45° FOV, 2352x1568px, color fundus image: 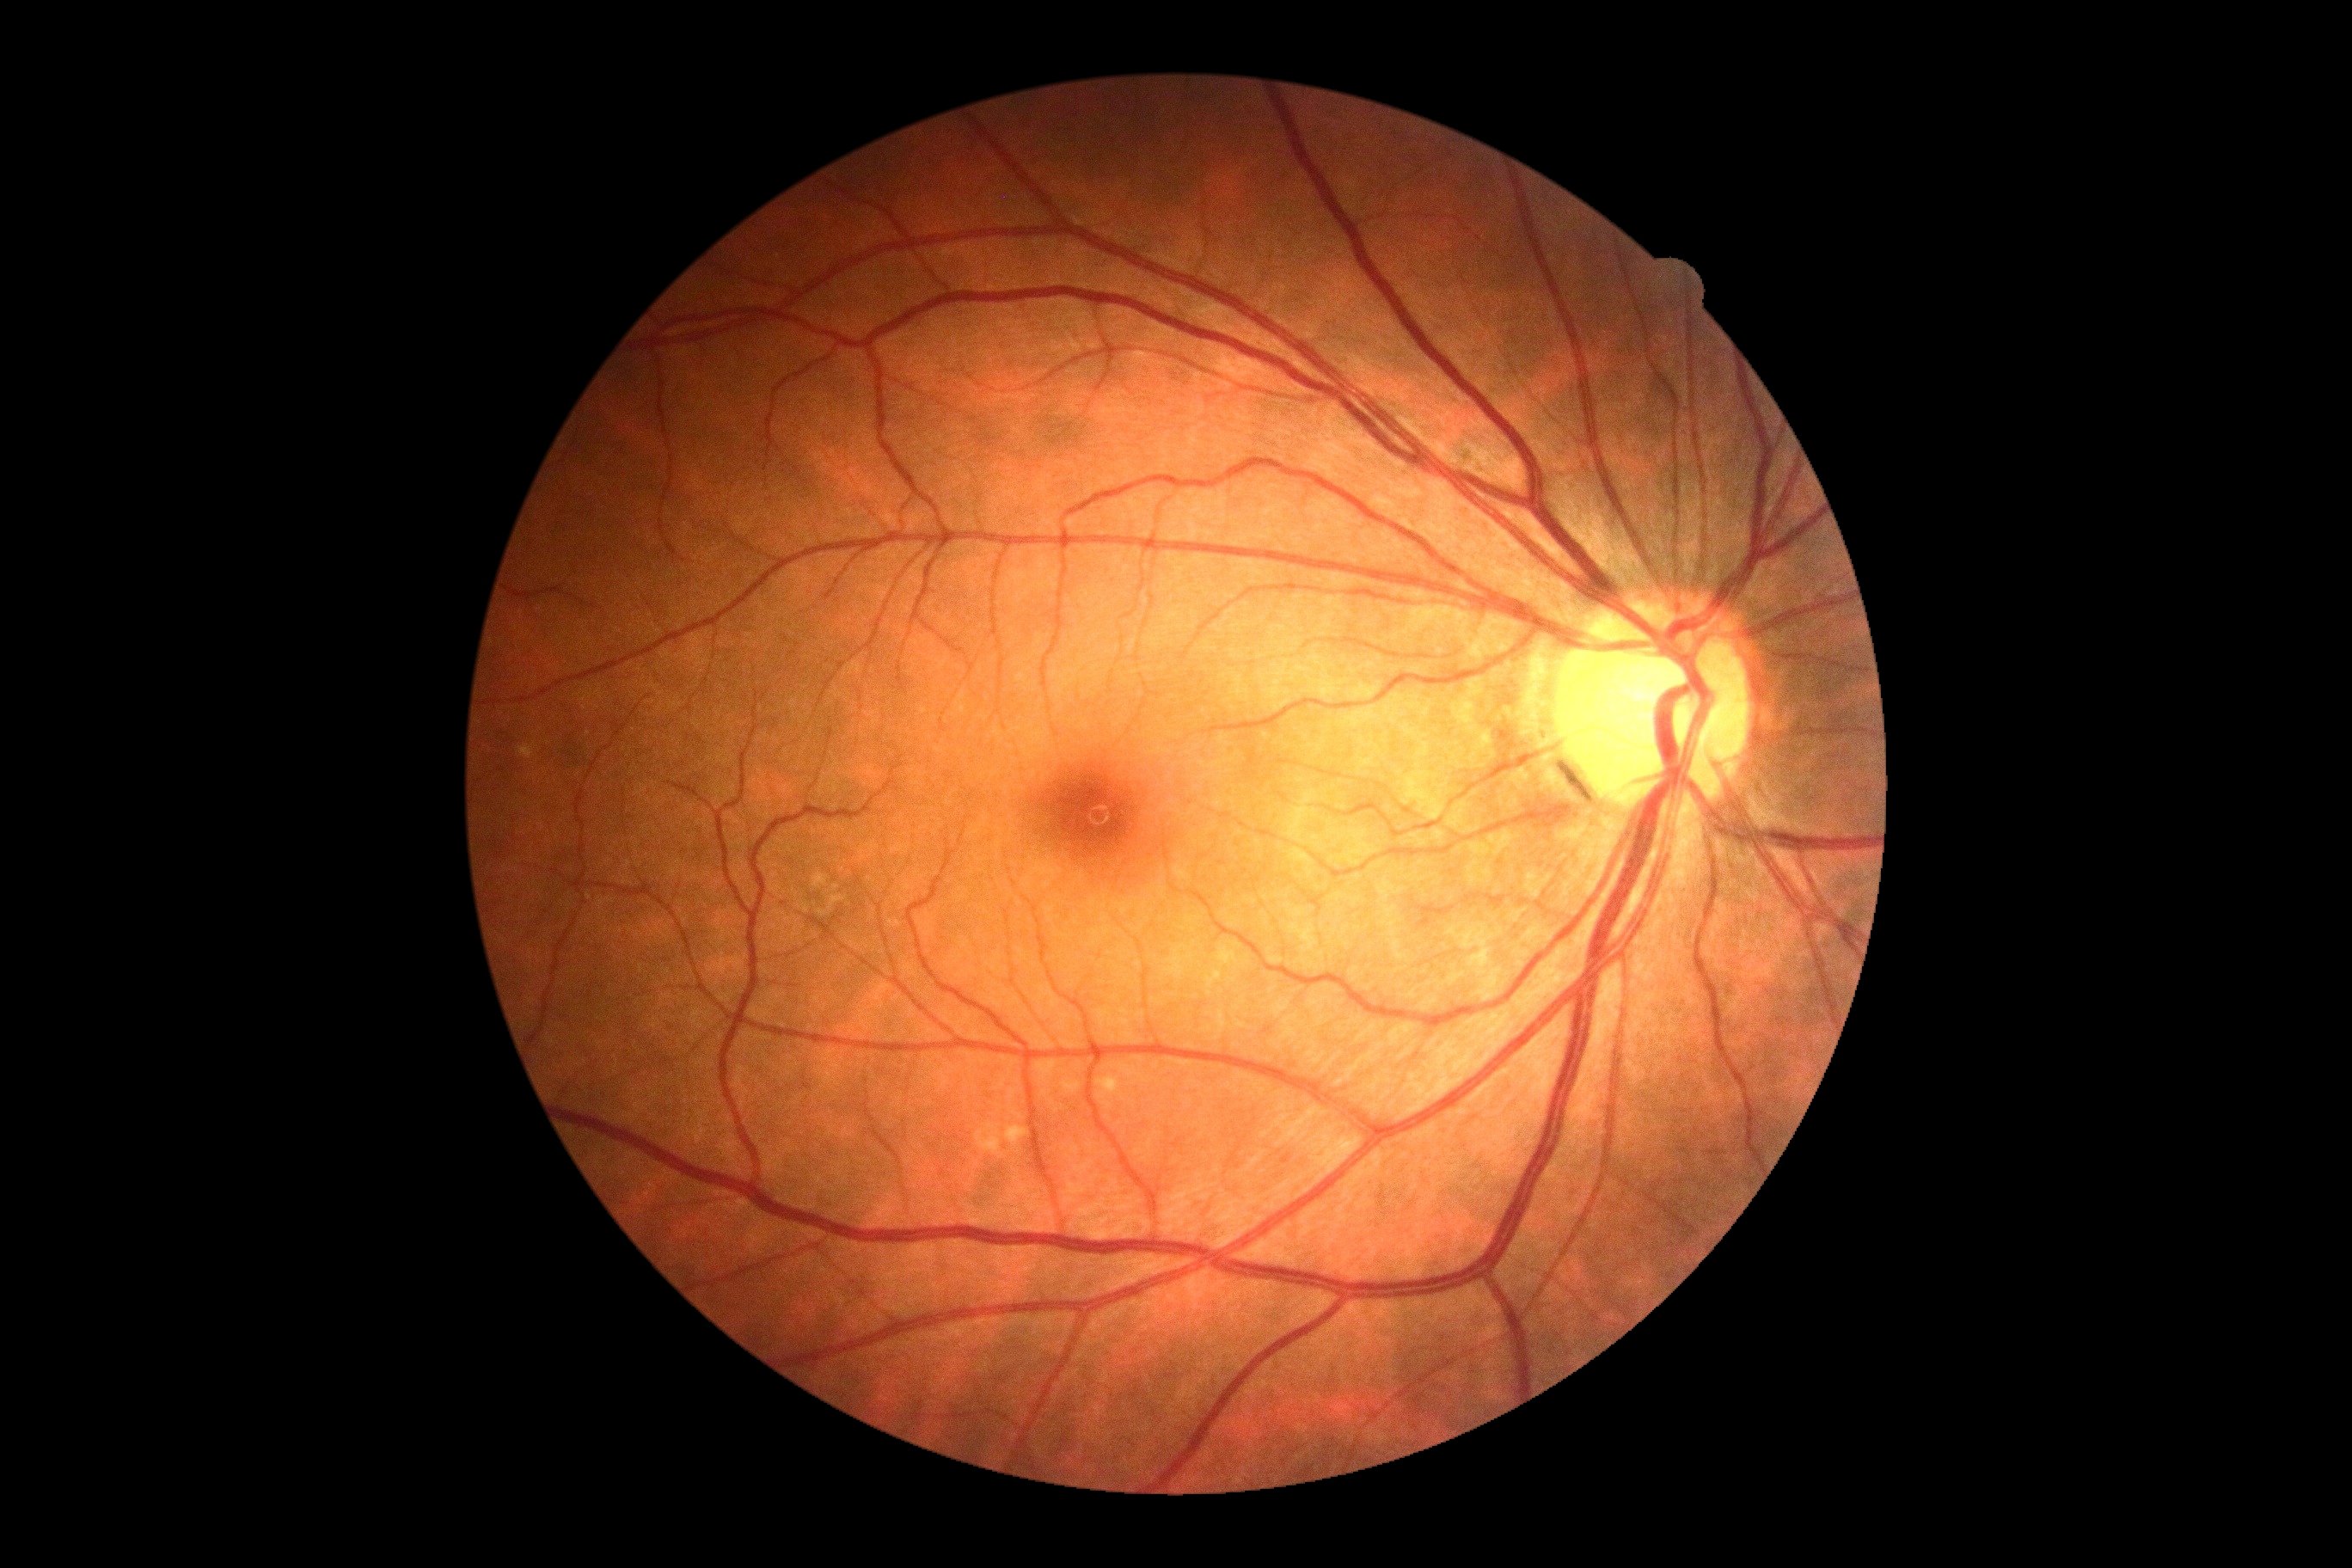
diabetic retinopathy (DR): no apparent diabetic retinopathy (grade 0).